Graded on the modified Davis scale, NIDEK AFC-230 fundus camera, 848x848px.
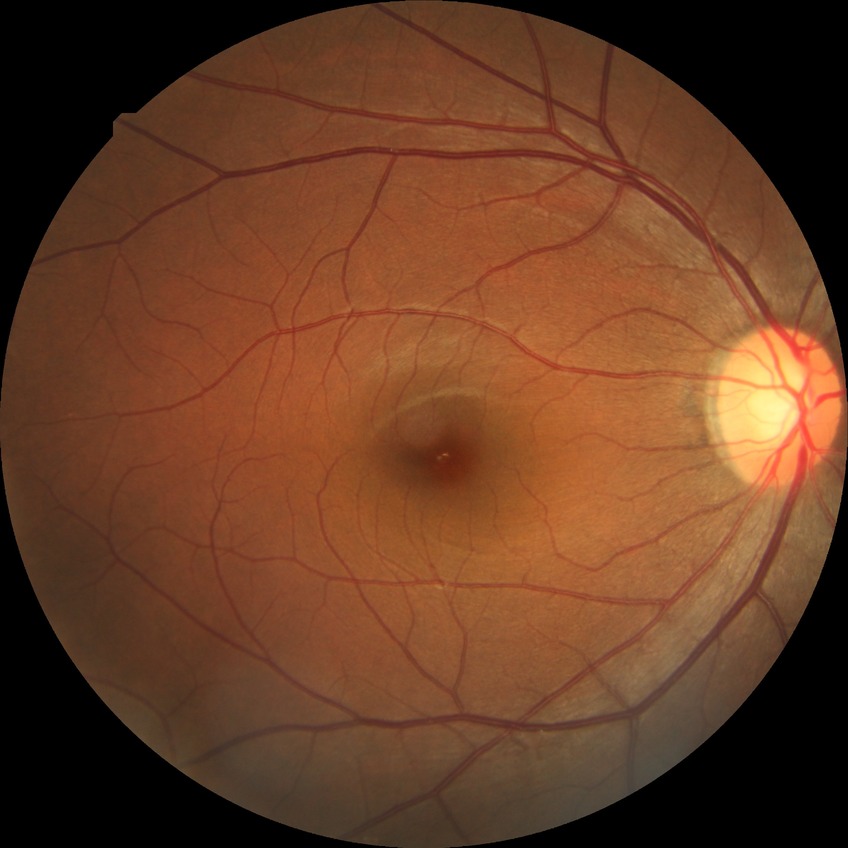 Diabetic retinopathy (DR): no diabetic retinopathy (NDR).